Tabletop color fundus camera image, image size 1534x1534:
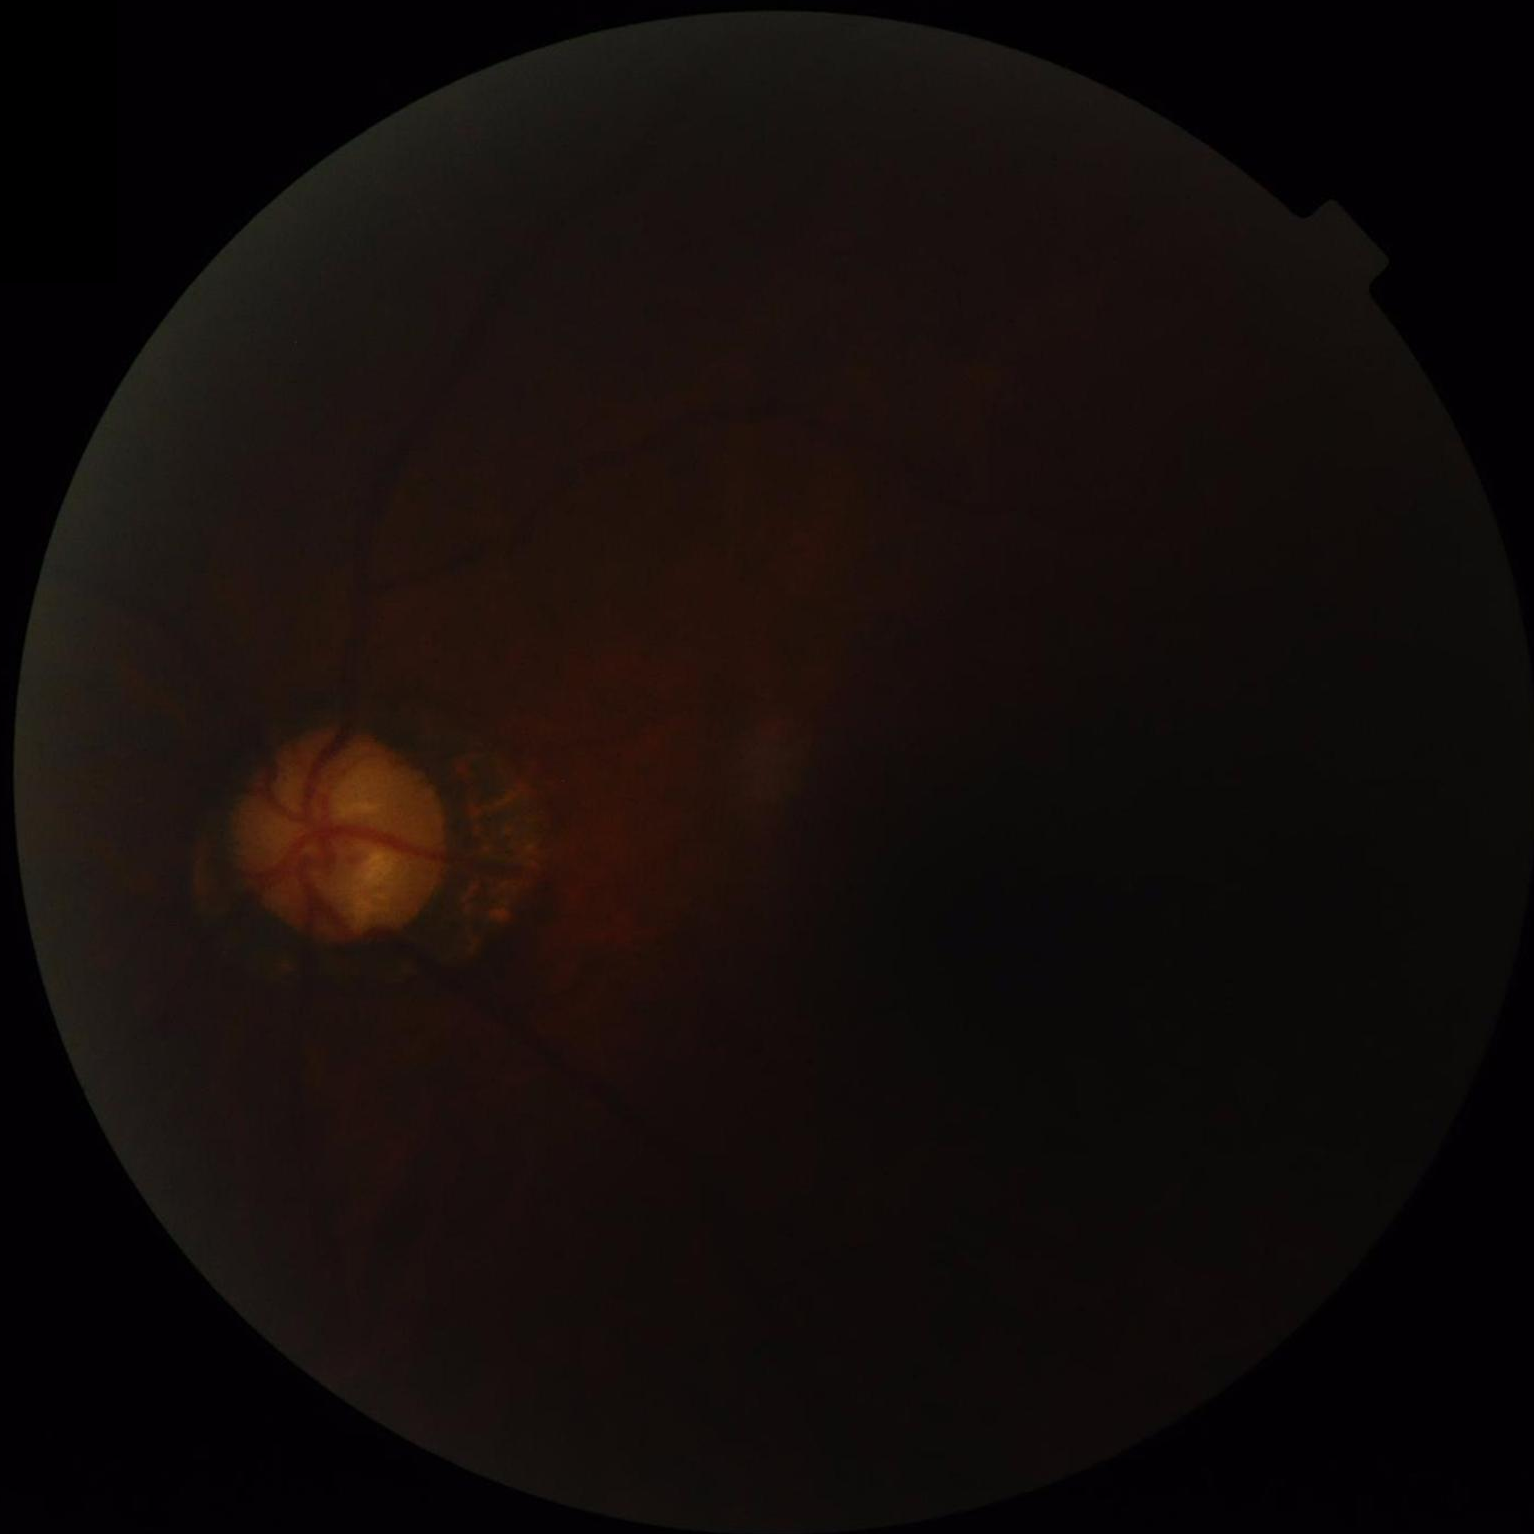
Overall quality = poor | Illumination/color = suboptimal | Contrast = poor | Clarity = reduced.